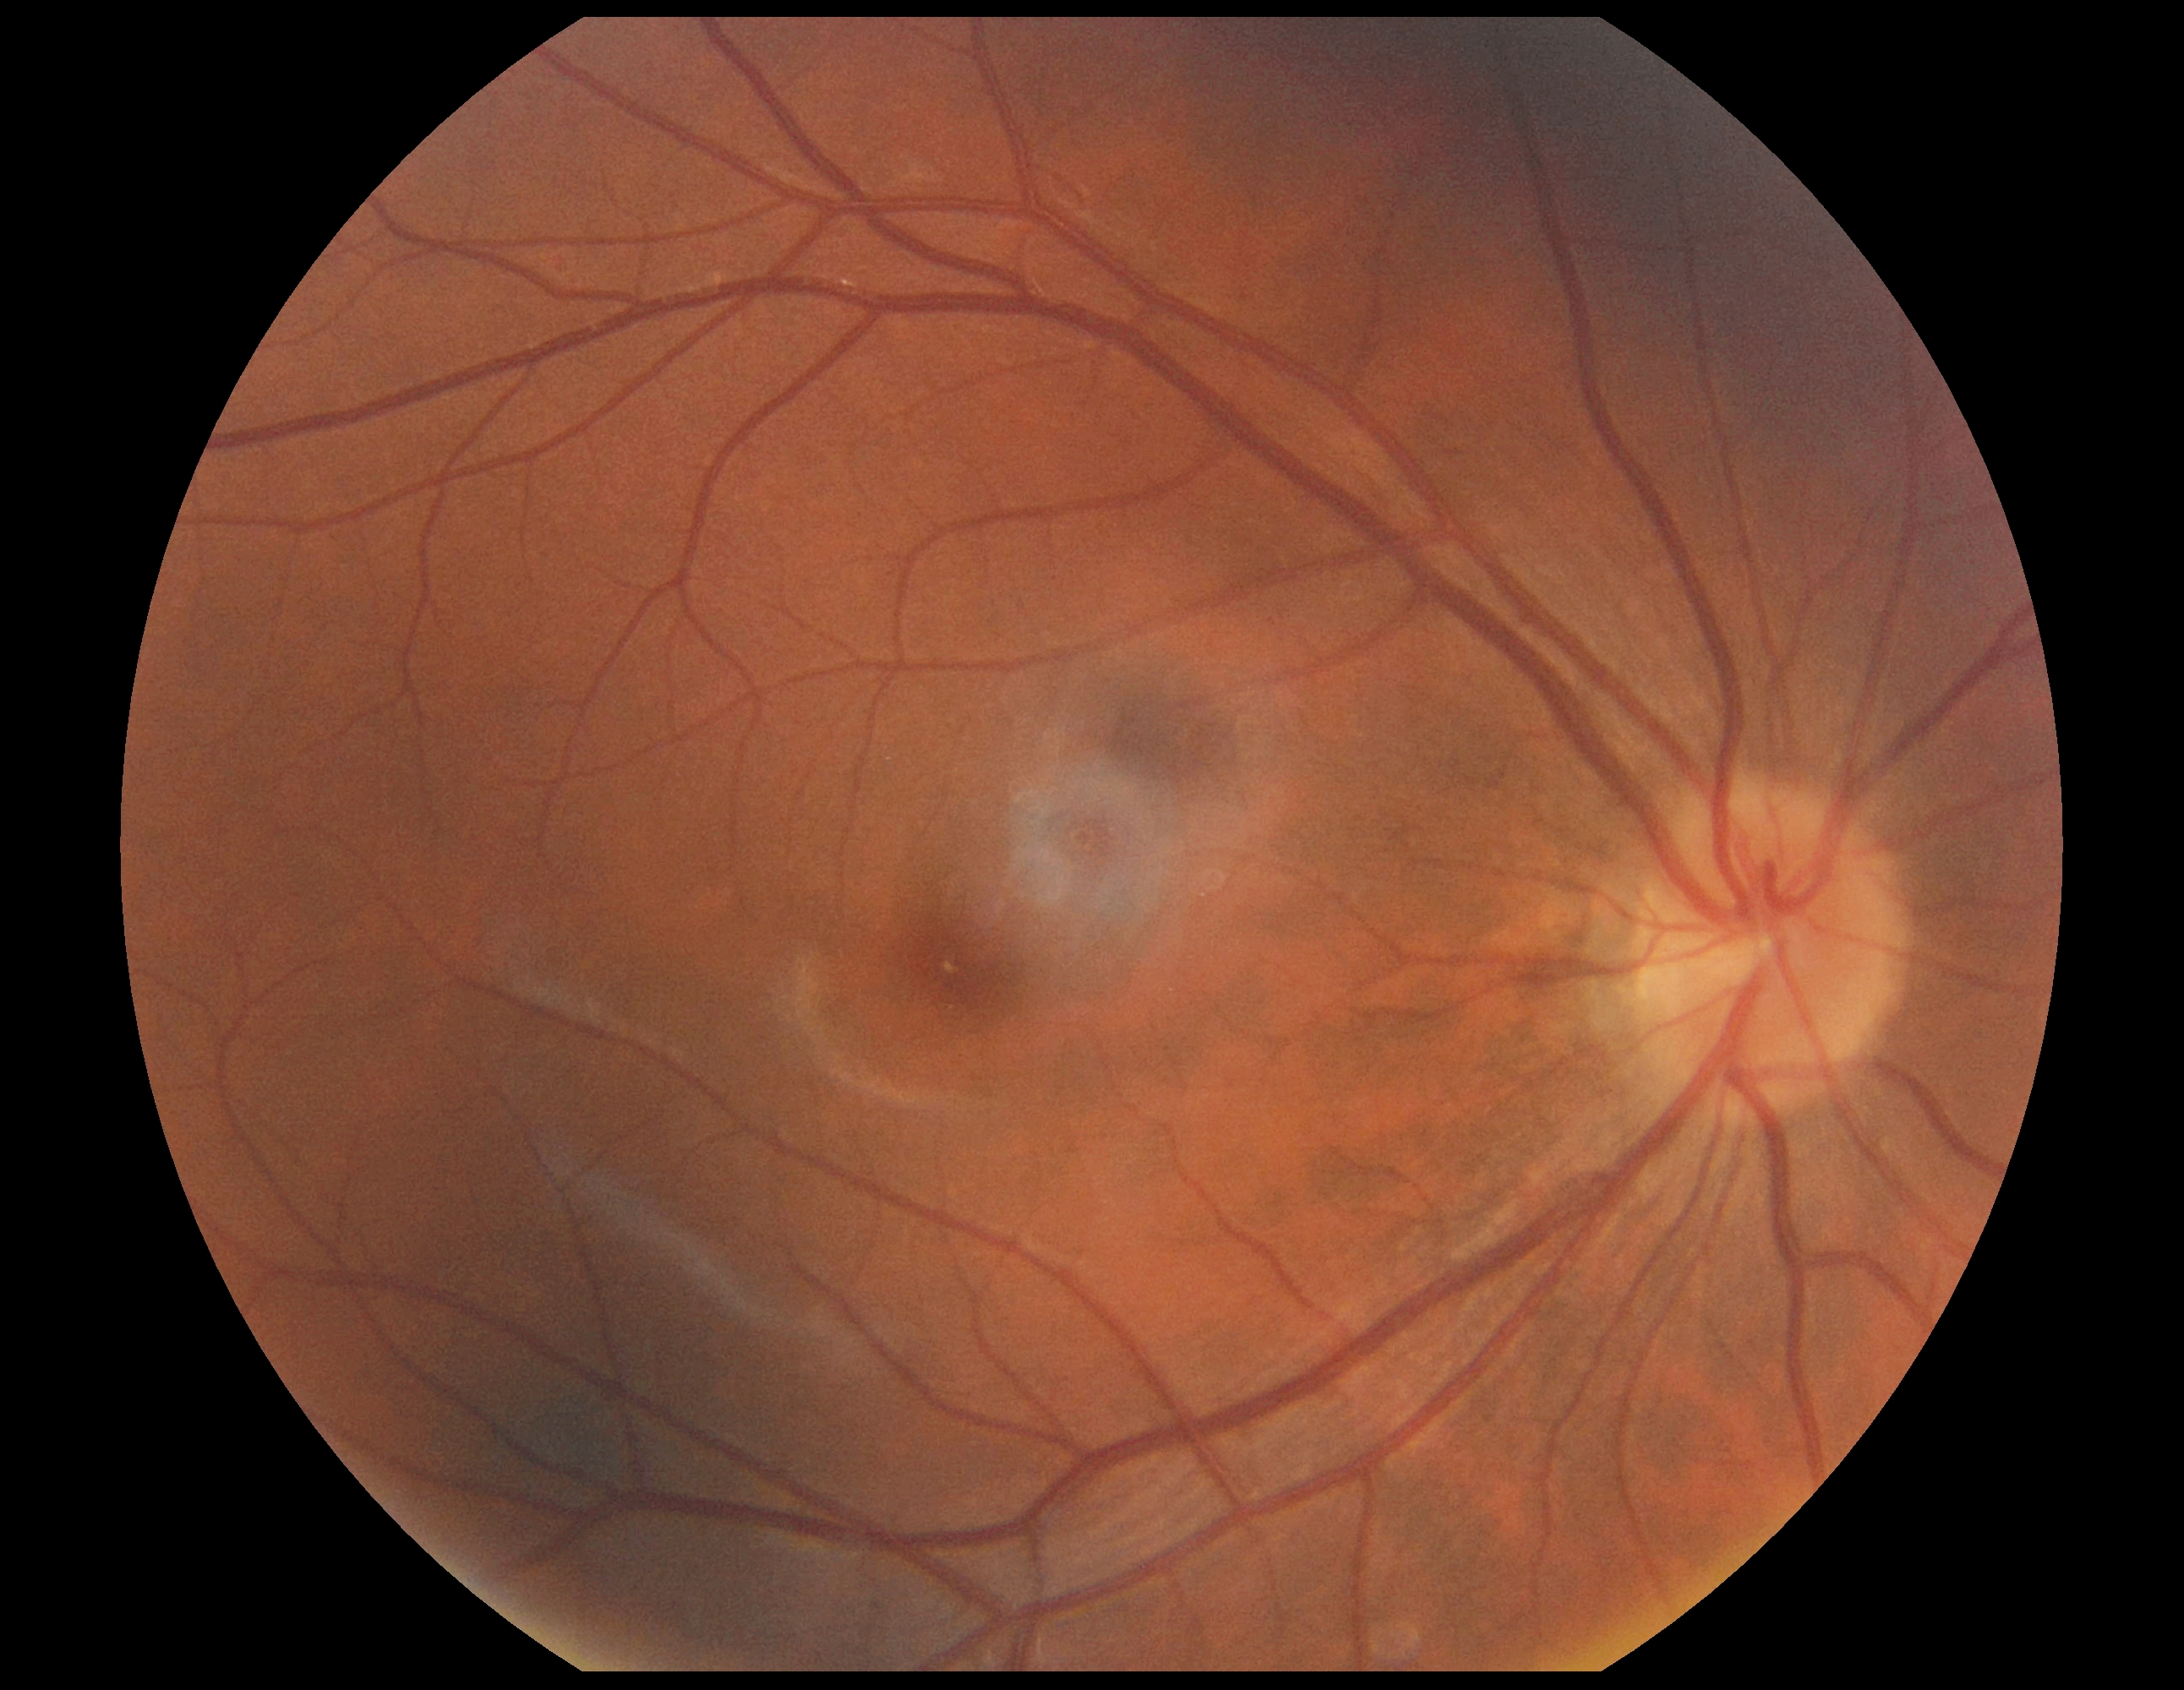
No apparent diabetic retinopathy.
Diabetic retinopathy (DR) is 0.